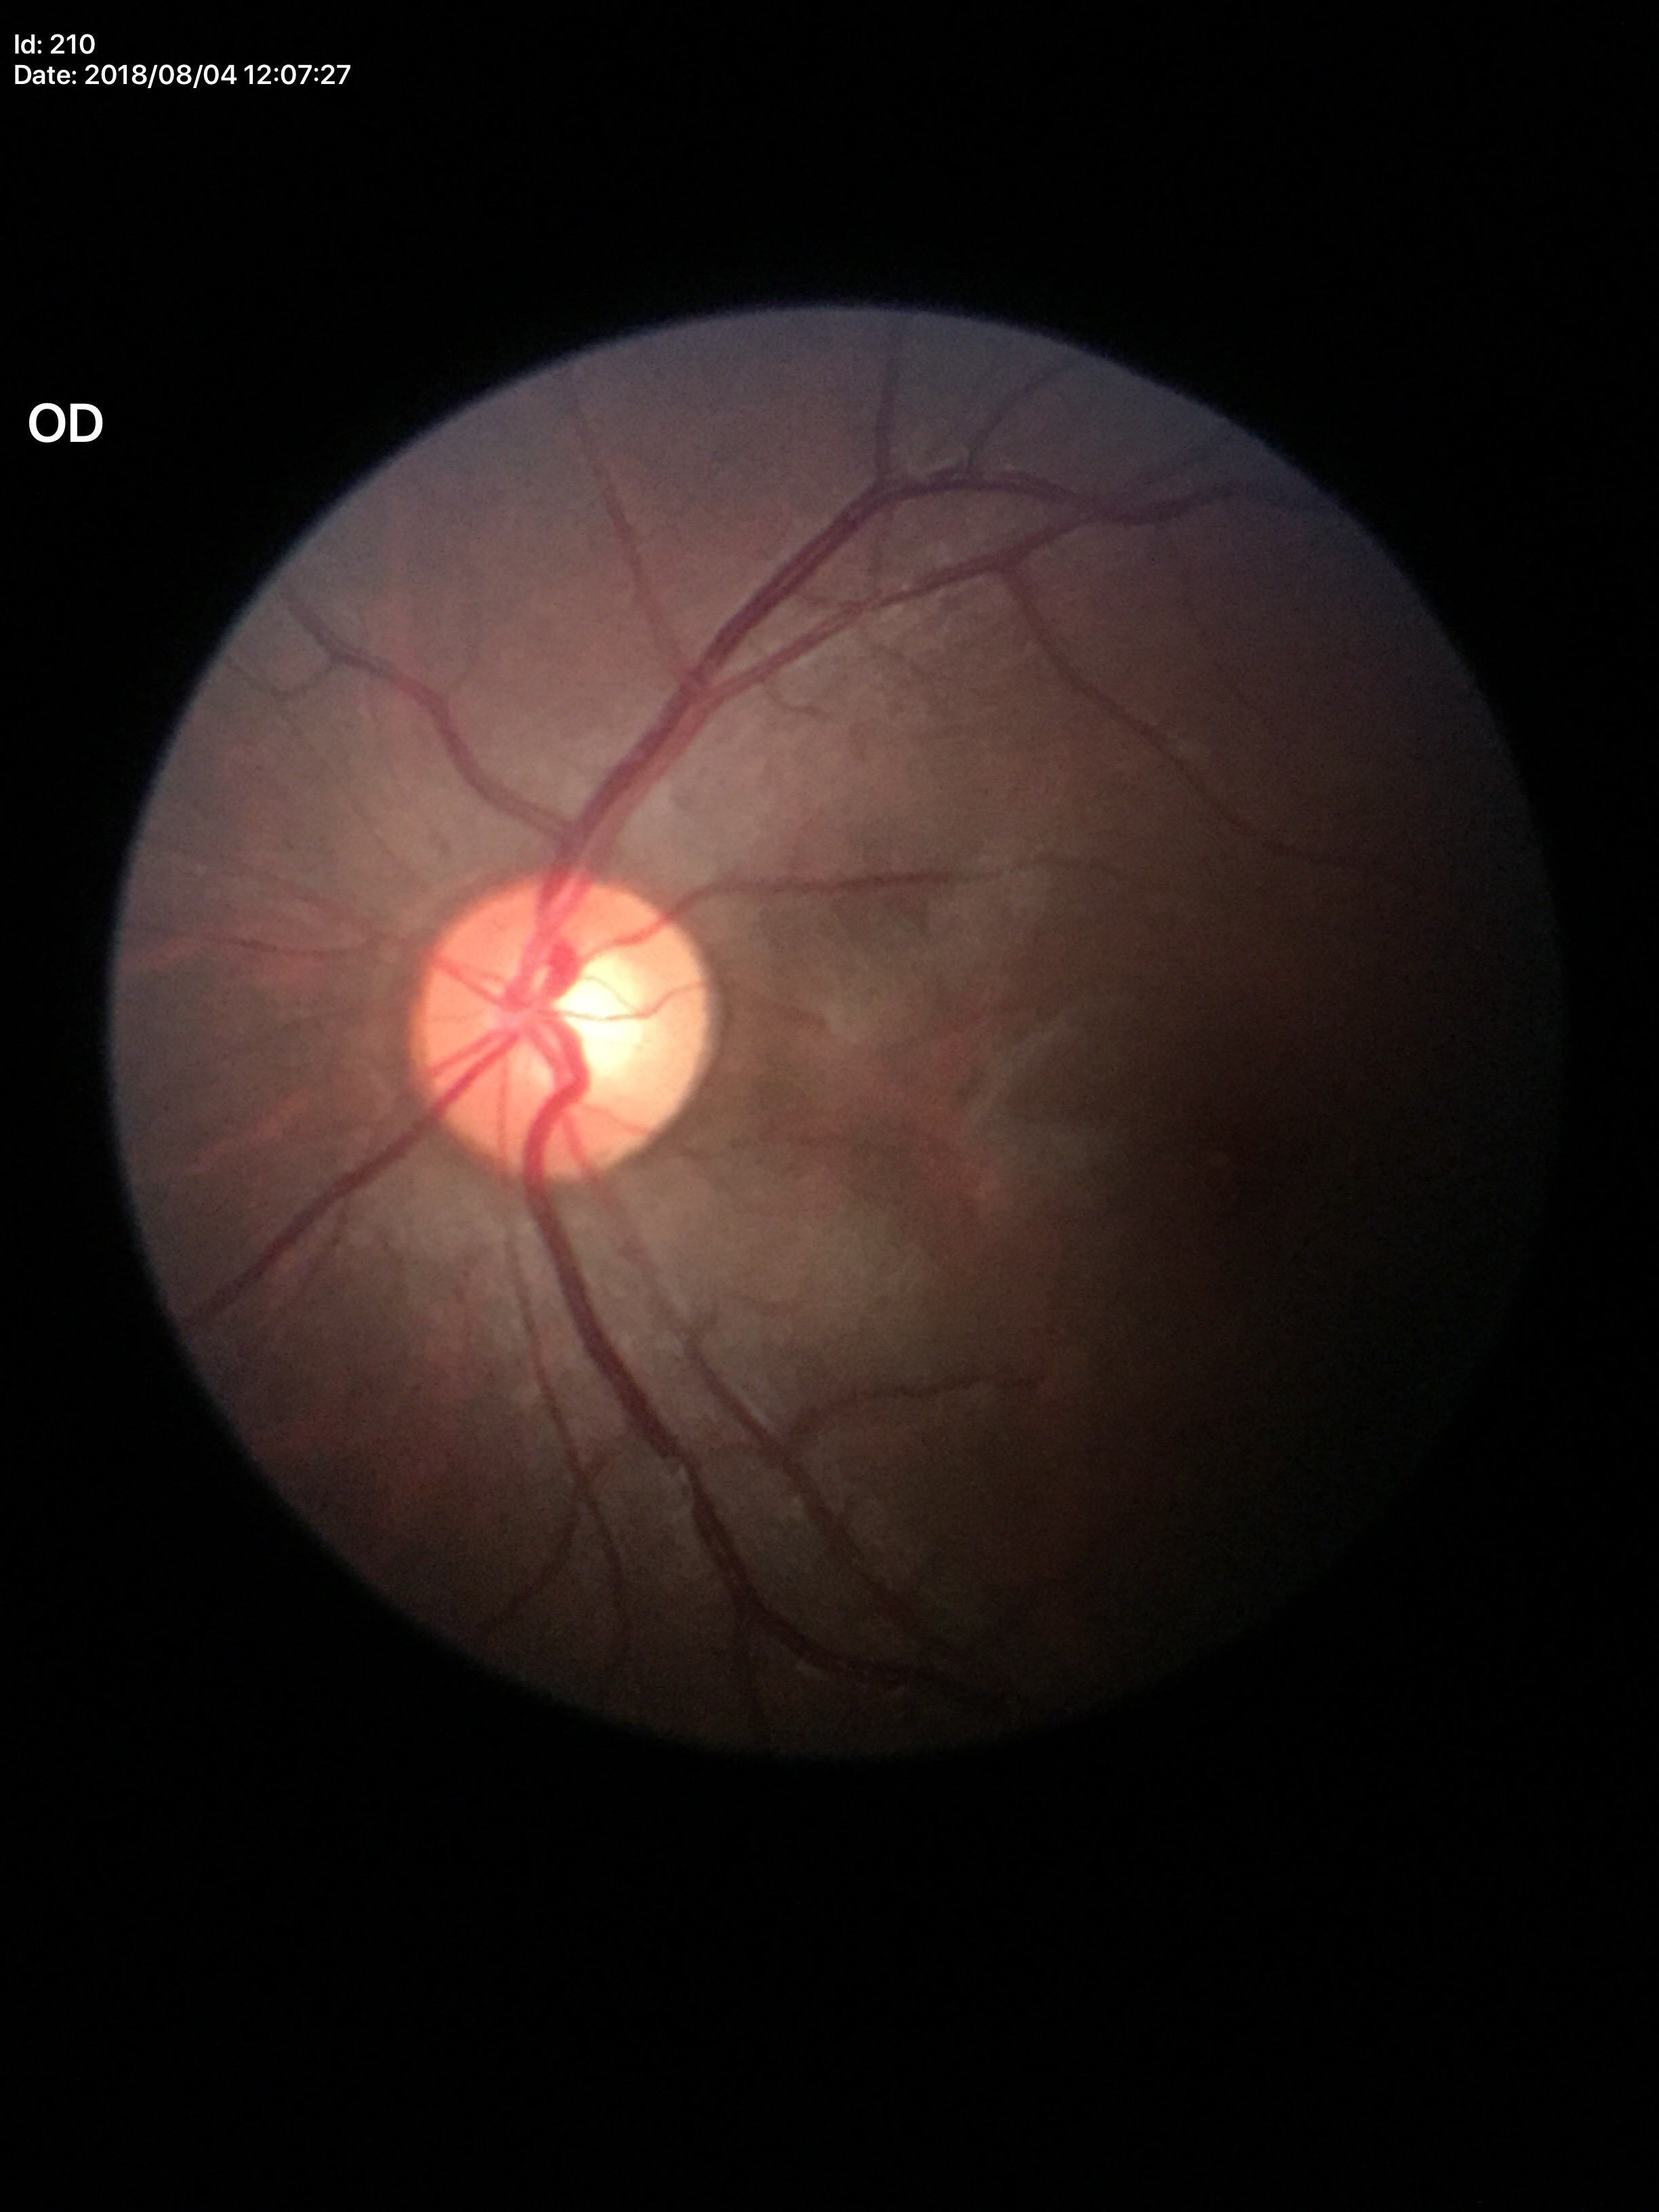

vertical cup-to-disc ratio (VCDR): 0.58 | Glaucoma assessment: no suspicious findings.